45° FOV — 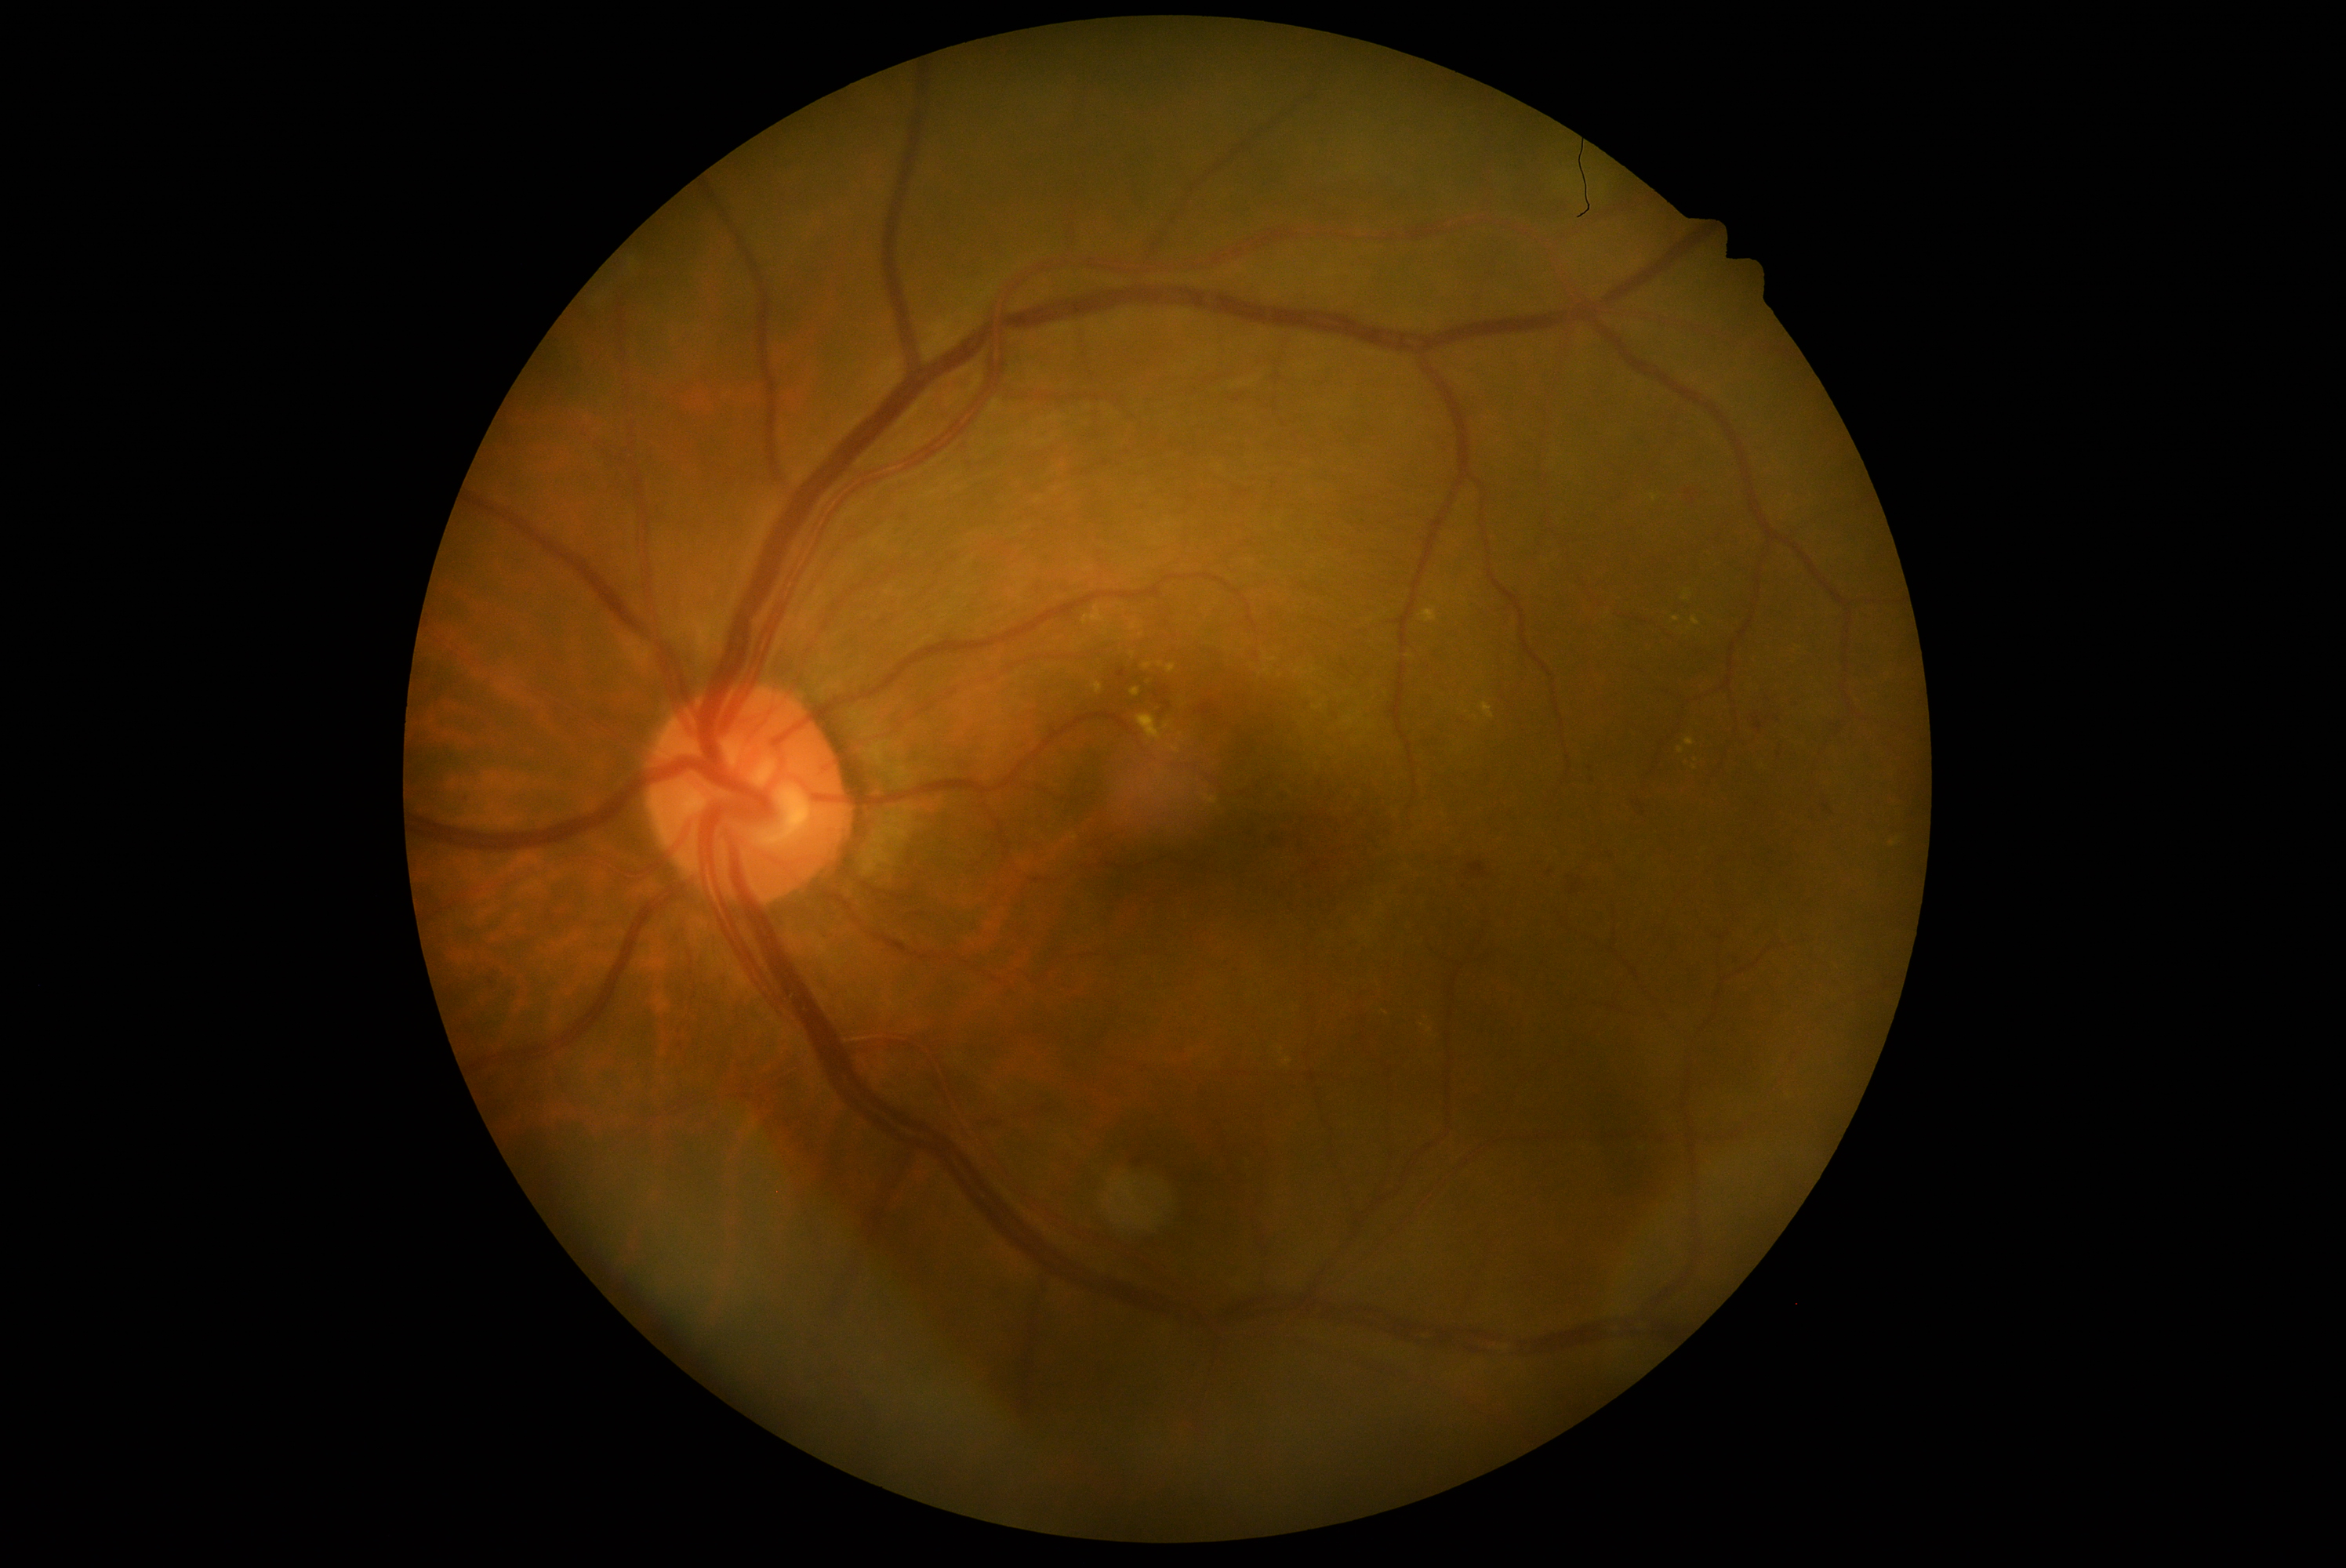
DR grade: 3/4.